Camera: NIDEK AFC-230, CFP, 848 by 848 pixels — 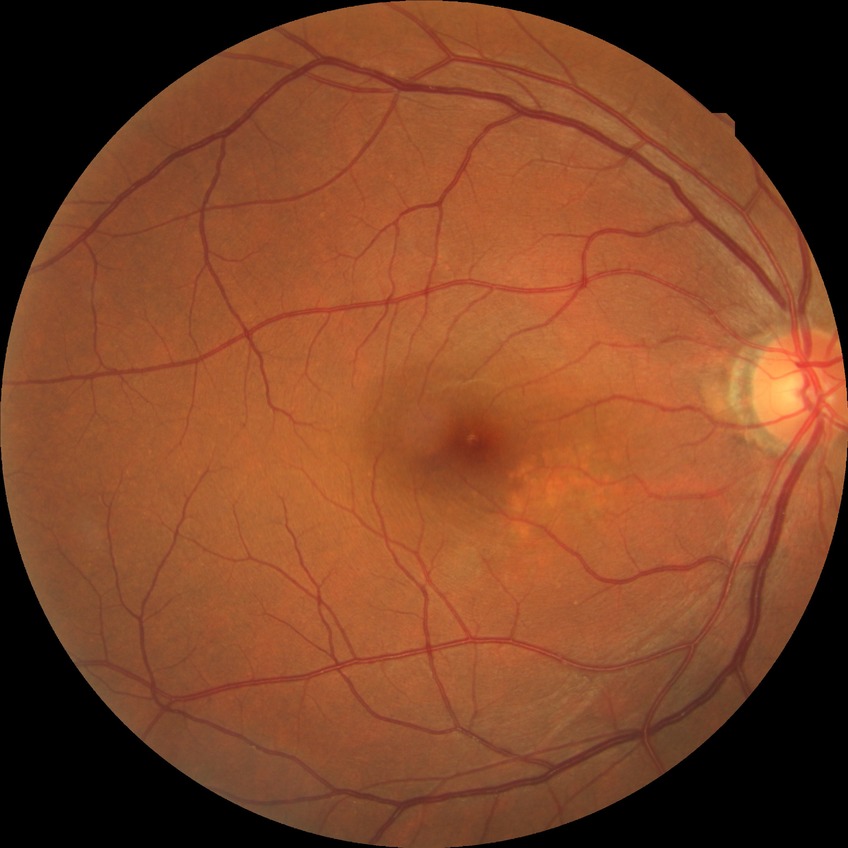

Diabetic retinopathy grade: no diabetic retinopathy.